Color fundus photograph, 2346x1568 — 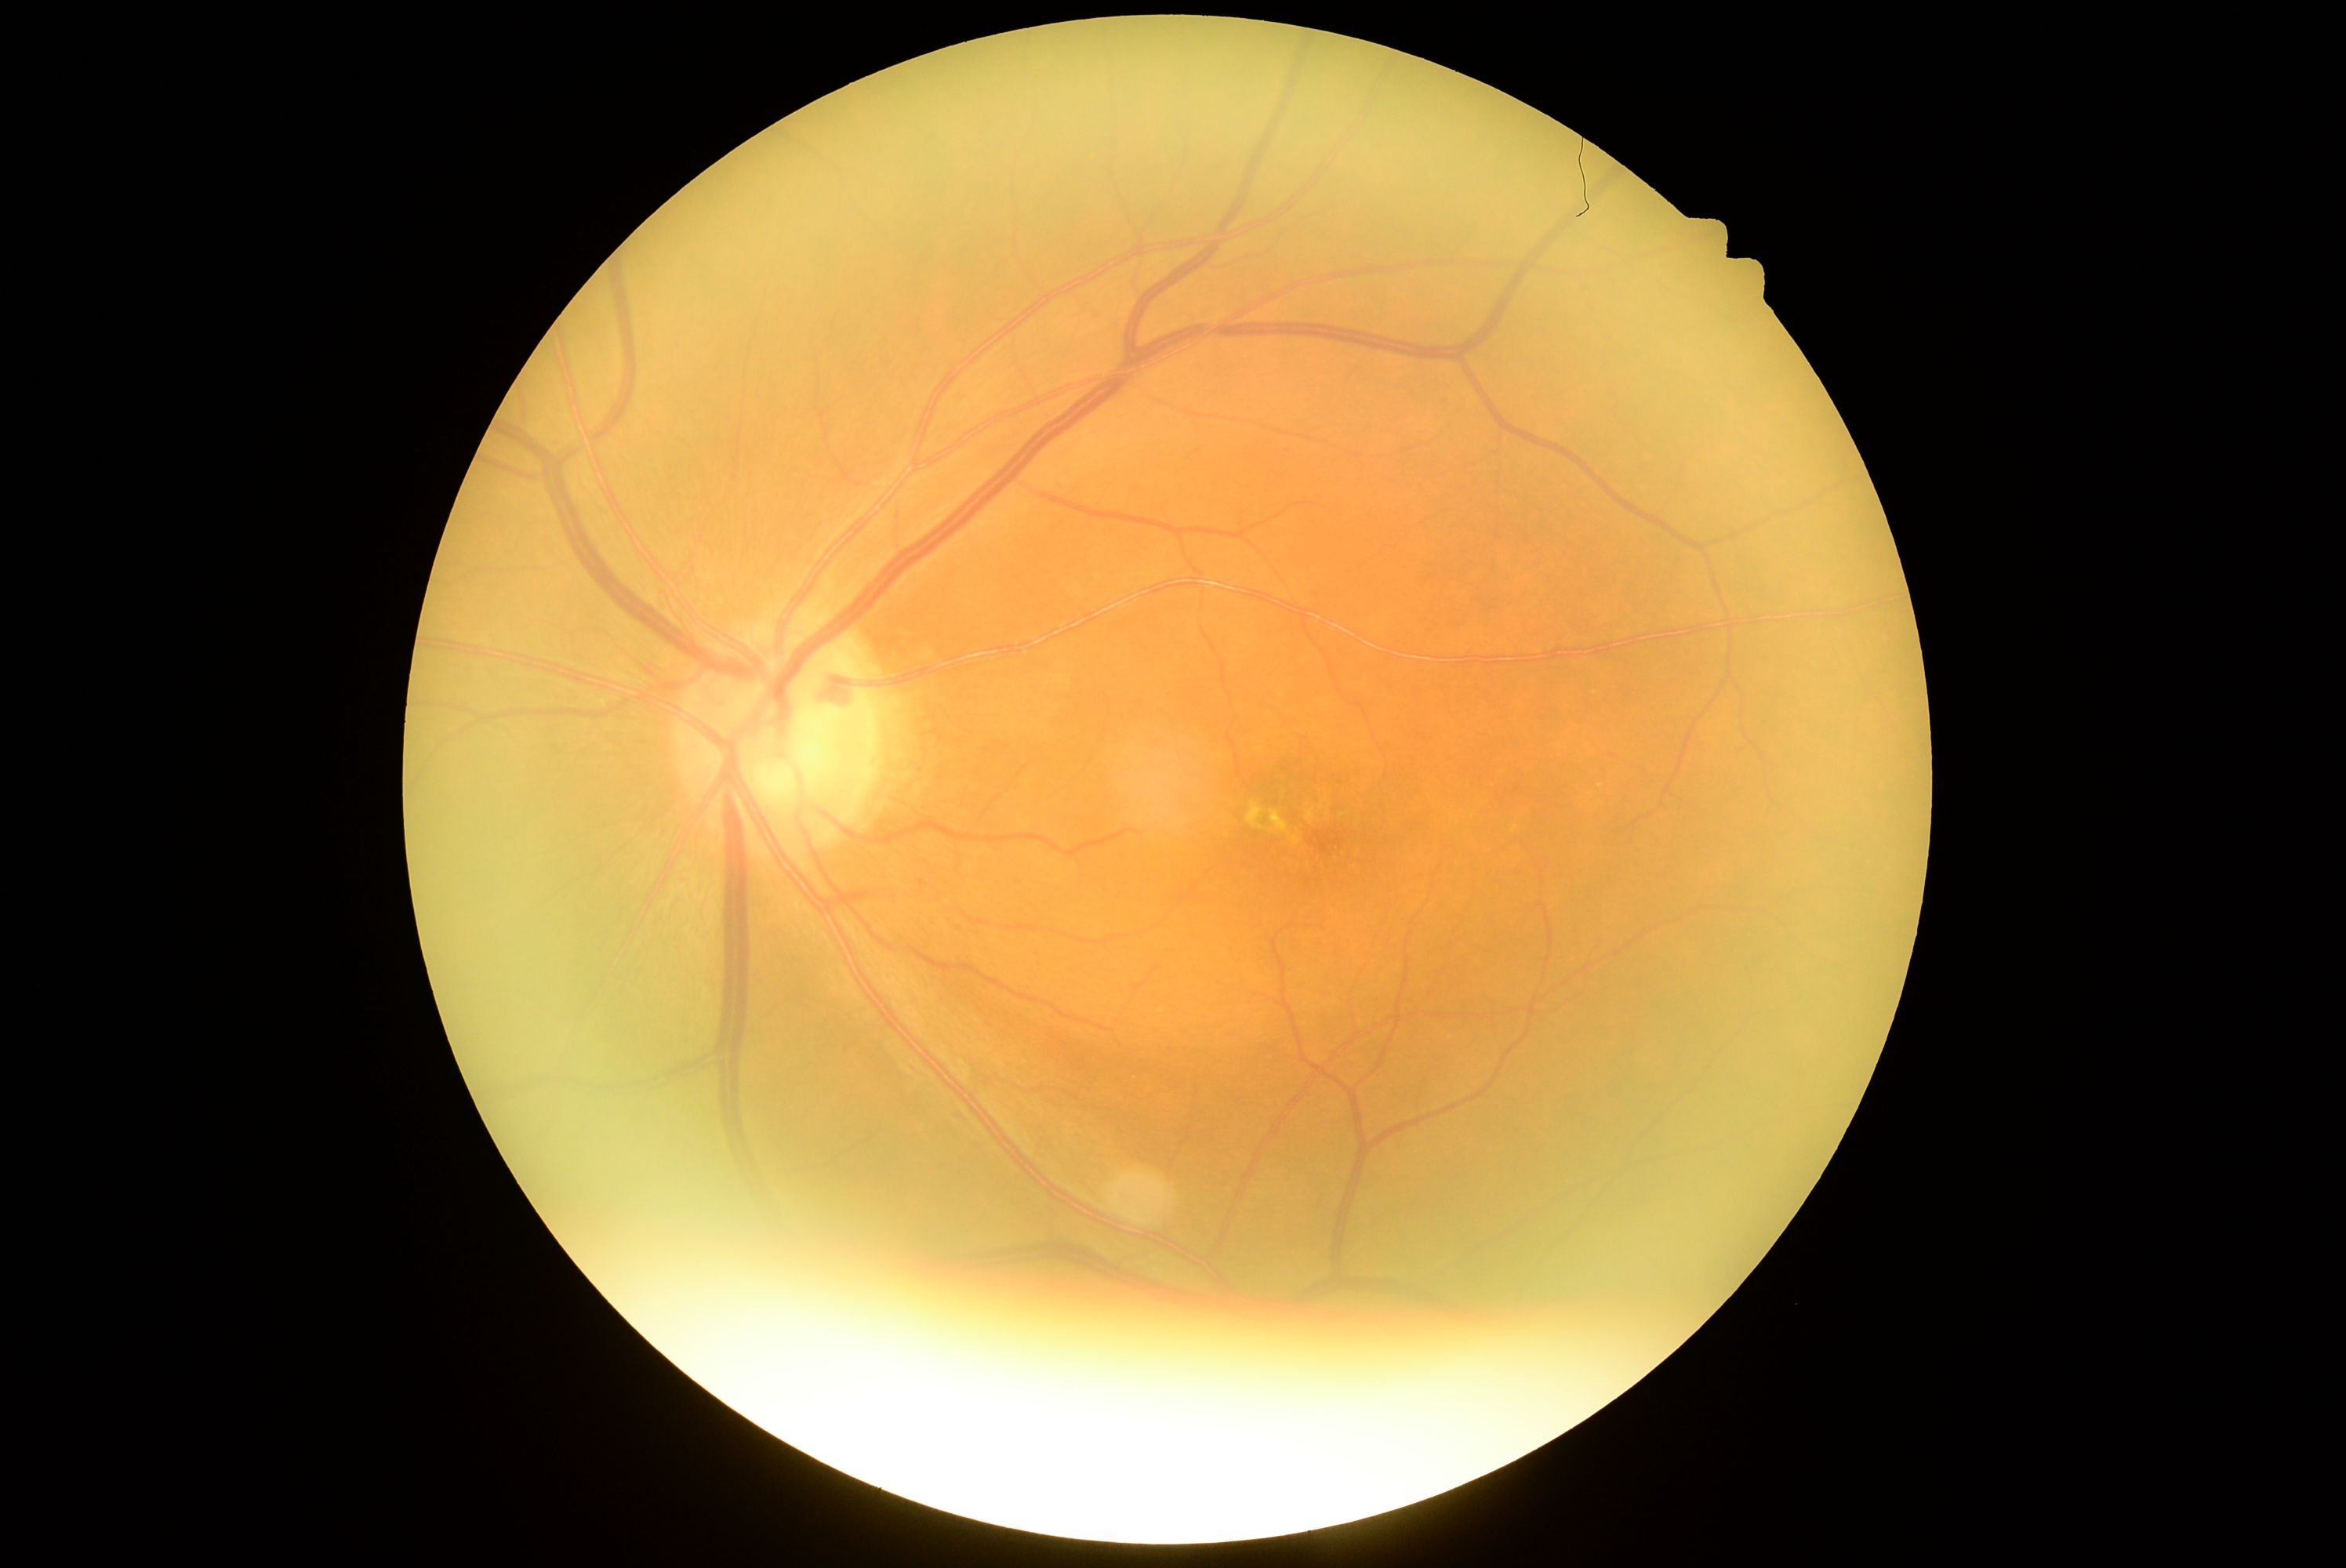 diabetic retinopathy (DR): grade 2.